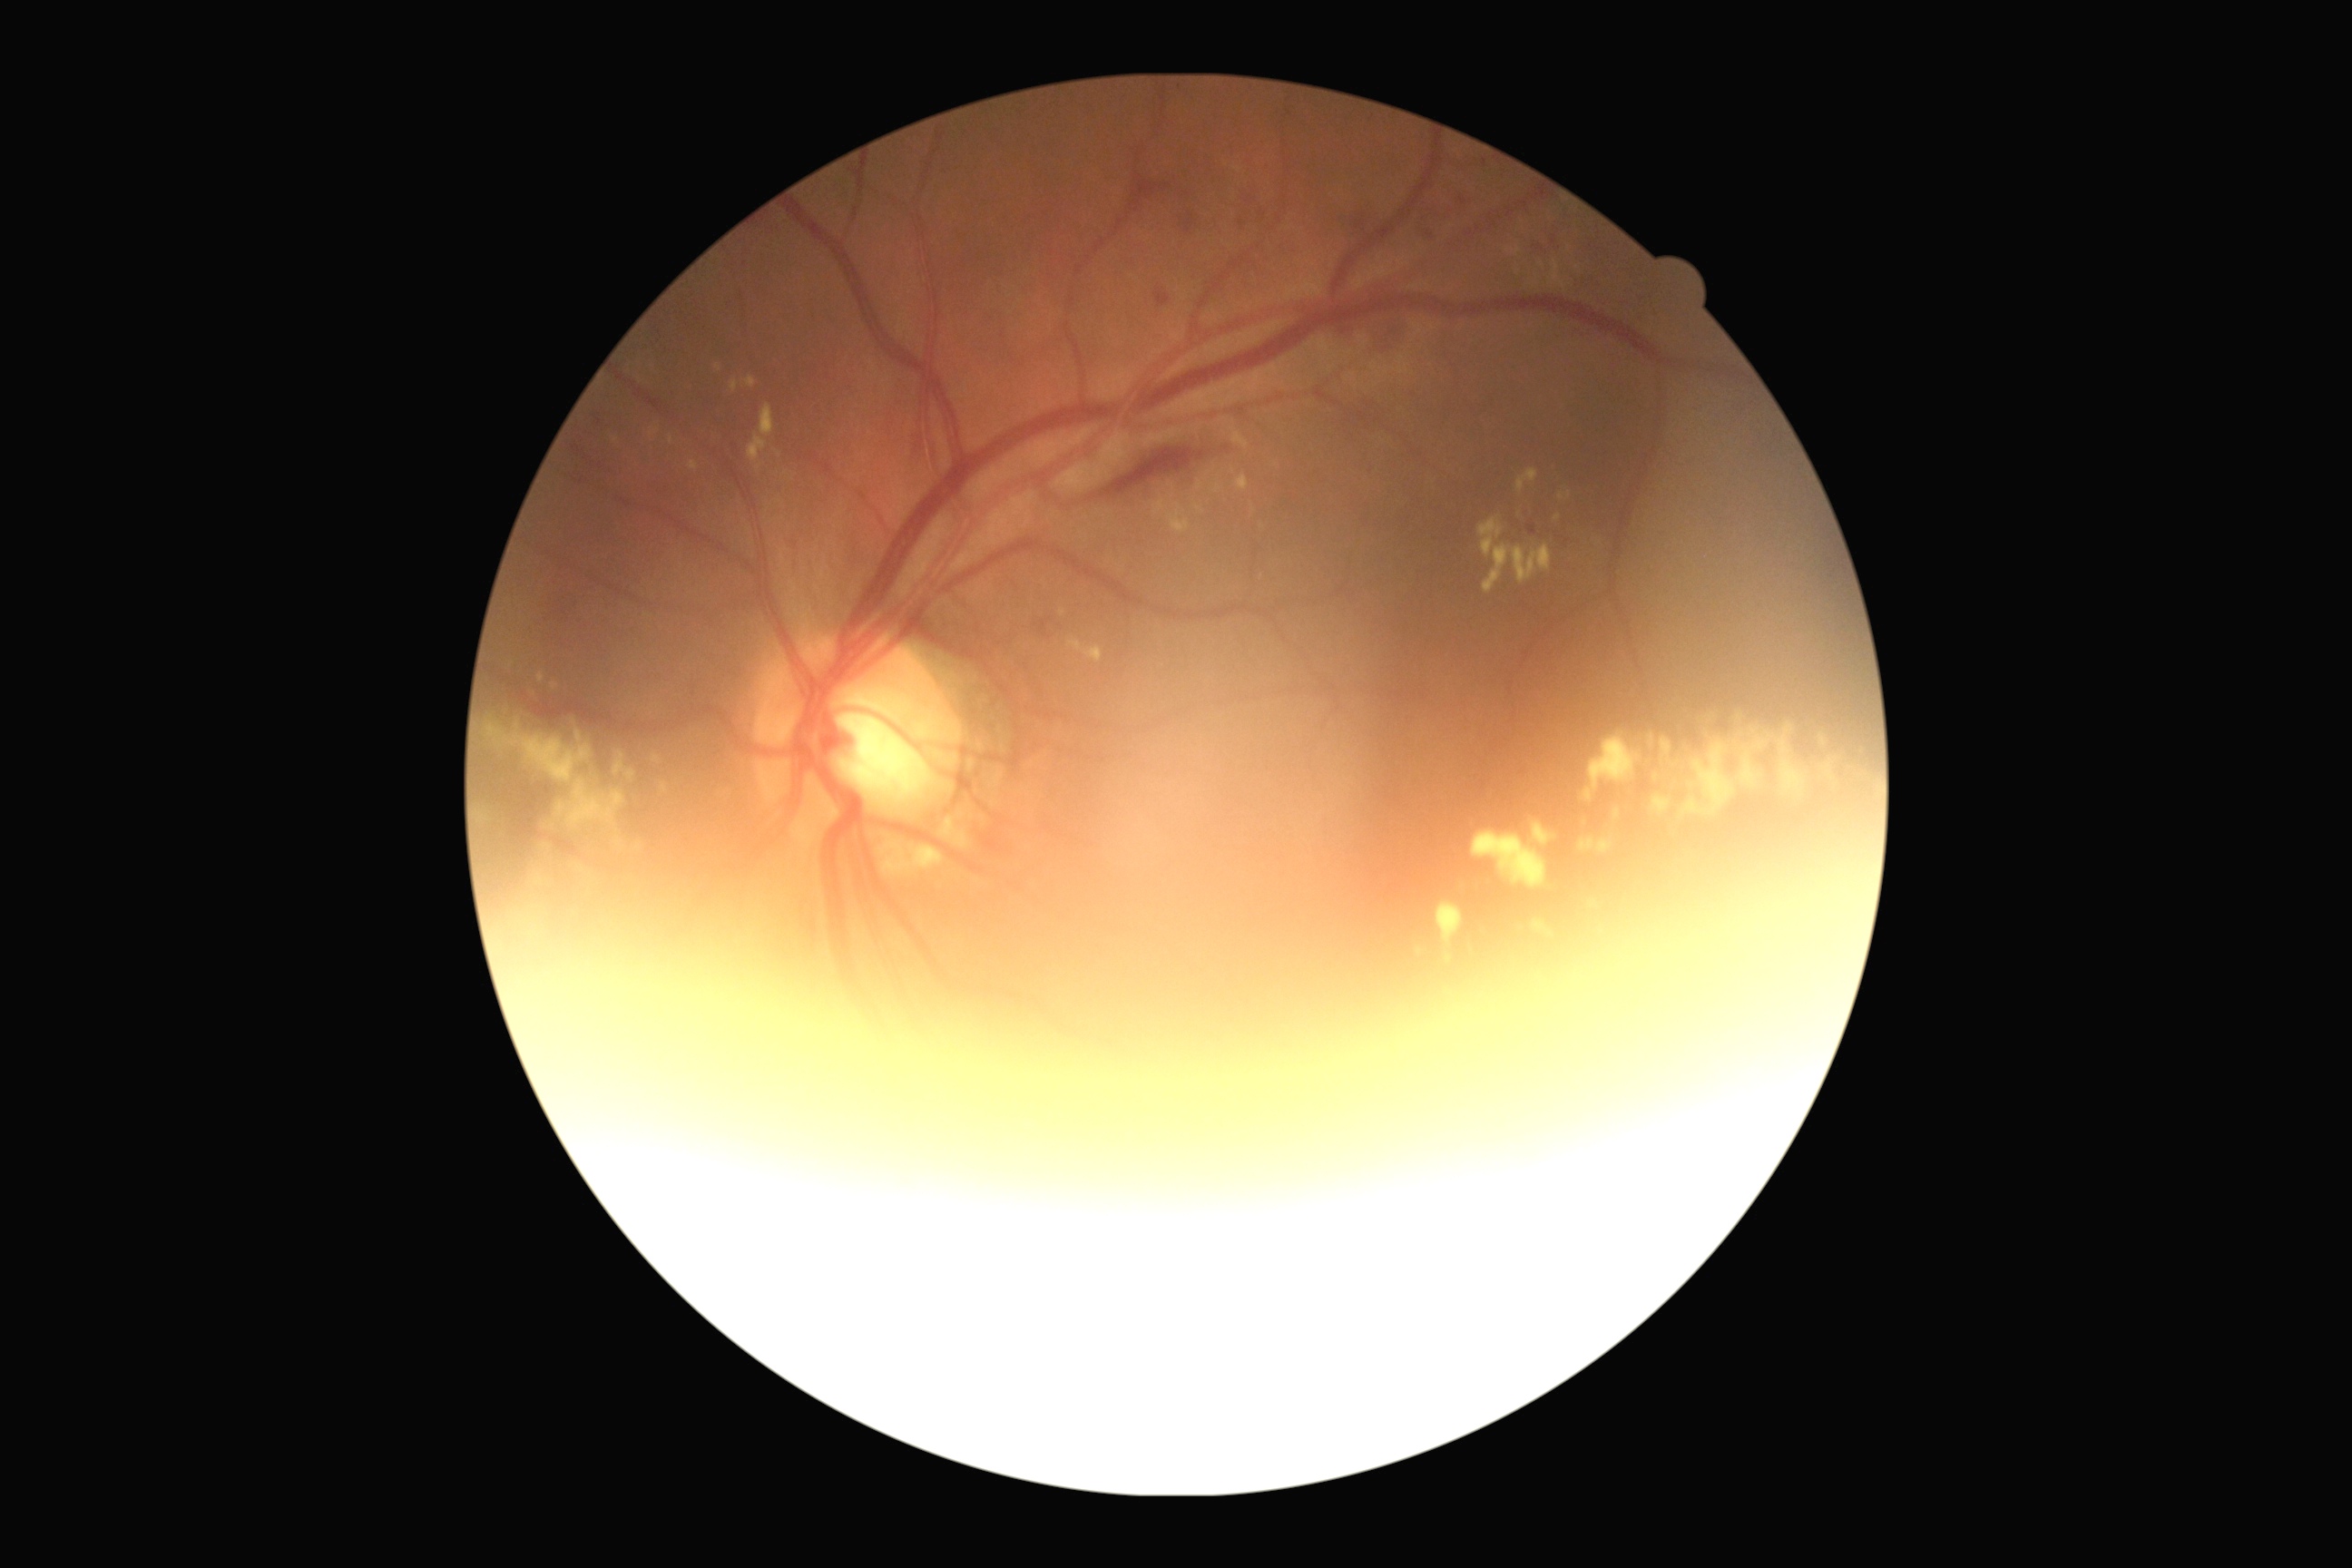

DR stage = grade 2 (moderate NPDR)